78 years old · refraction: sphere +1 D, cylinder -1.5 D, axis 80° · visual field mean deviation: -6.75 dB · intraocular pressure (IOP): 20 mmHg · central corneal thickness 563 µm · sex: male
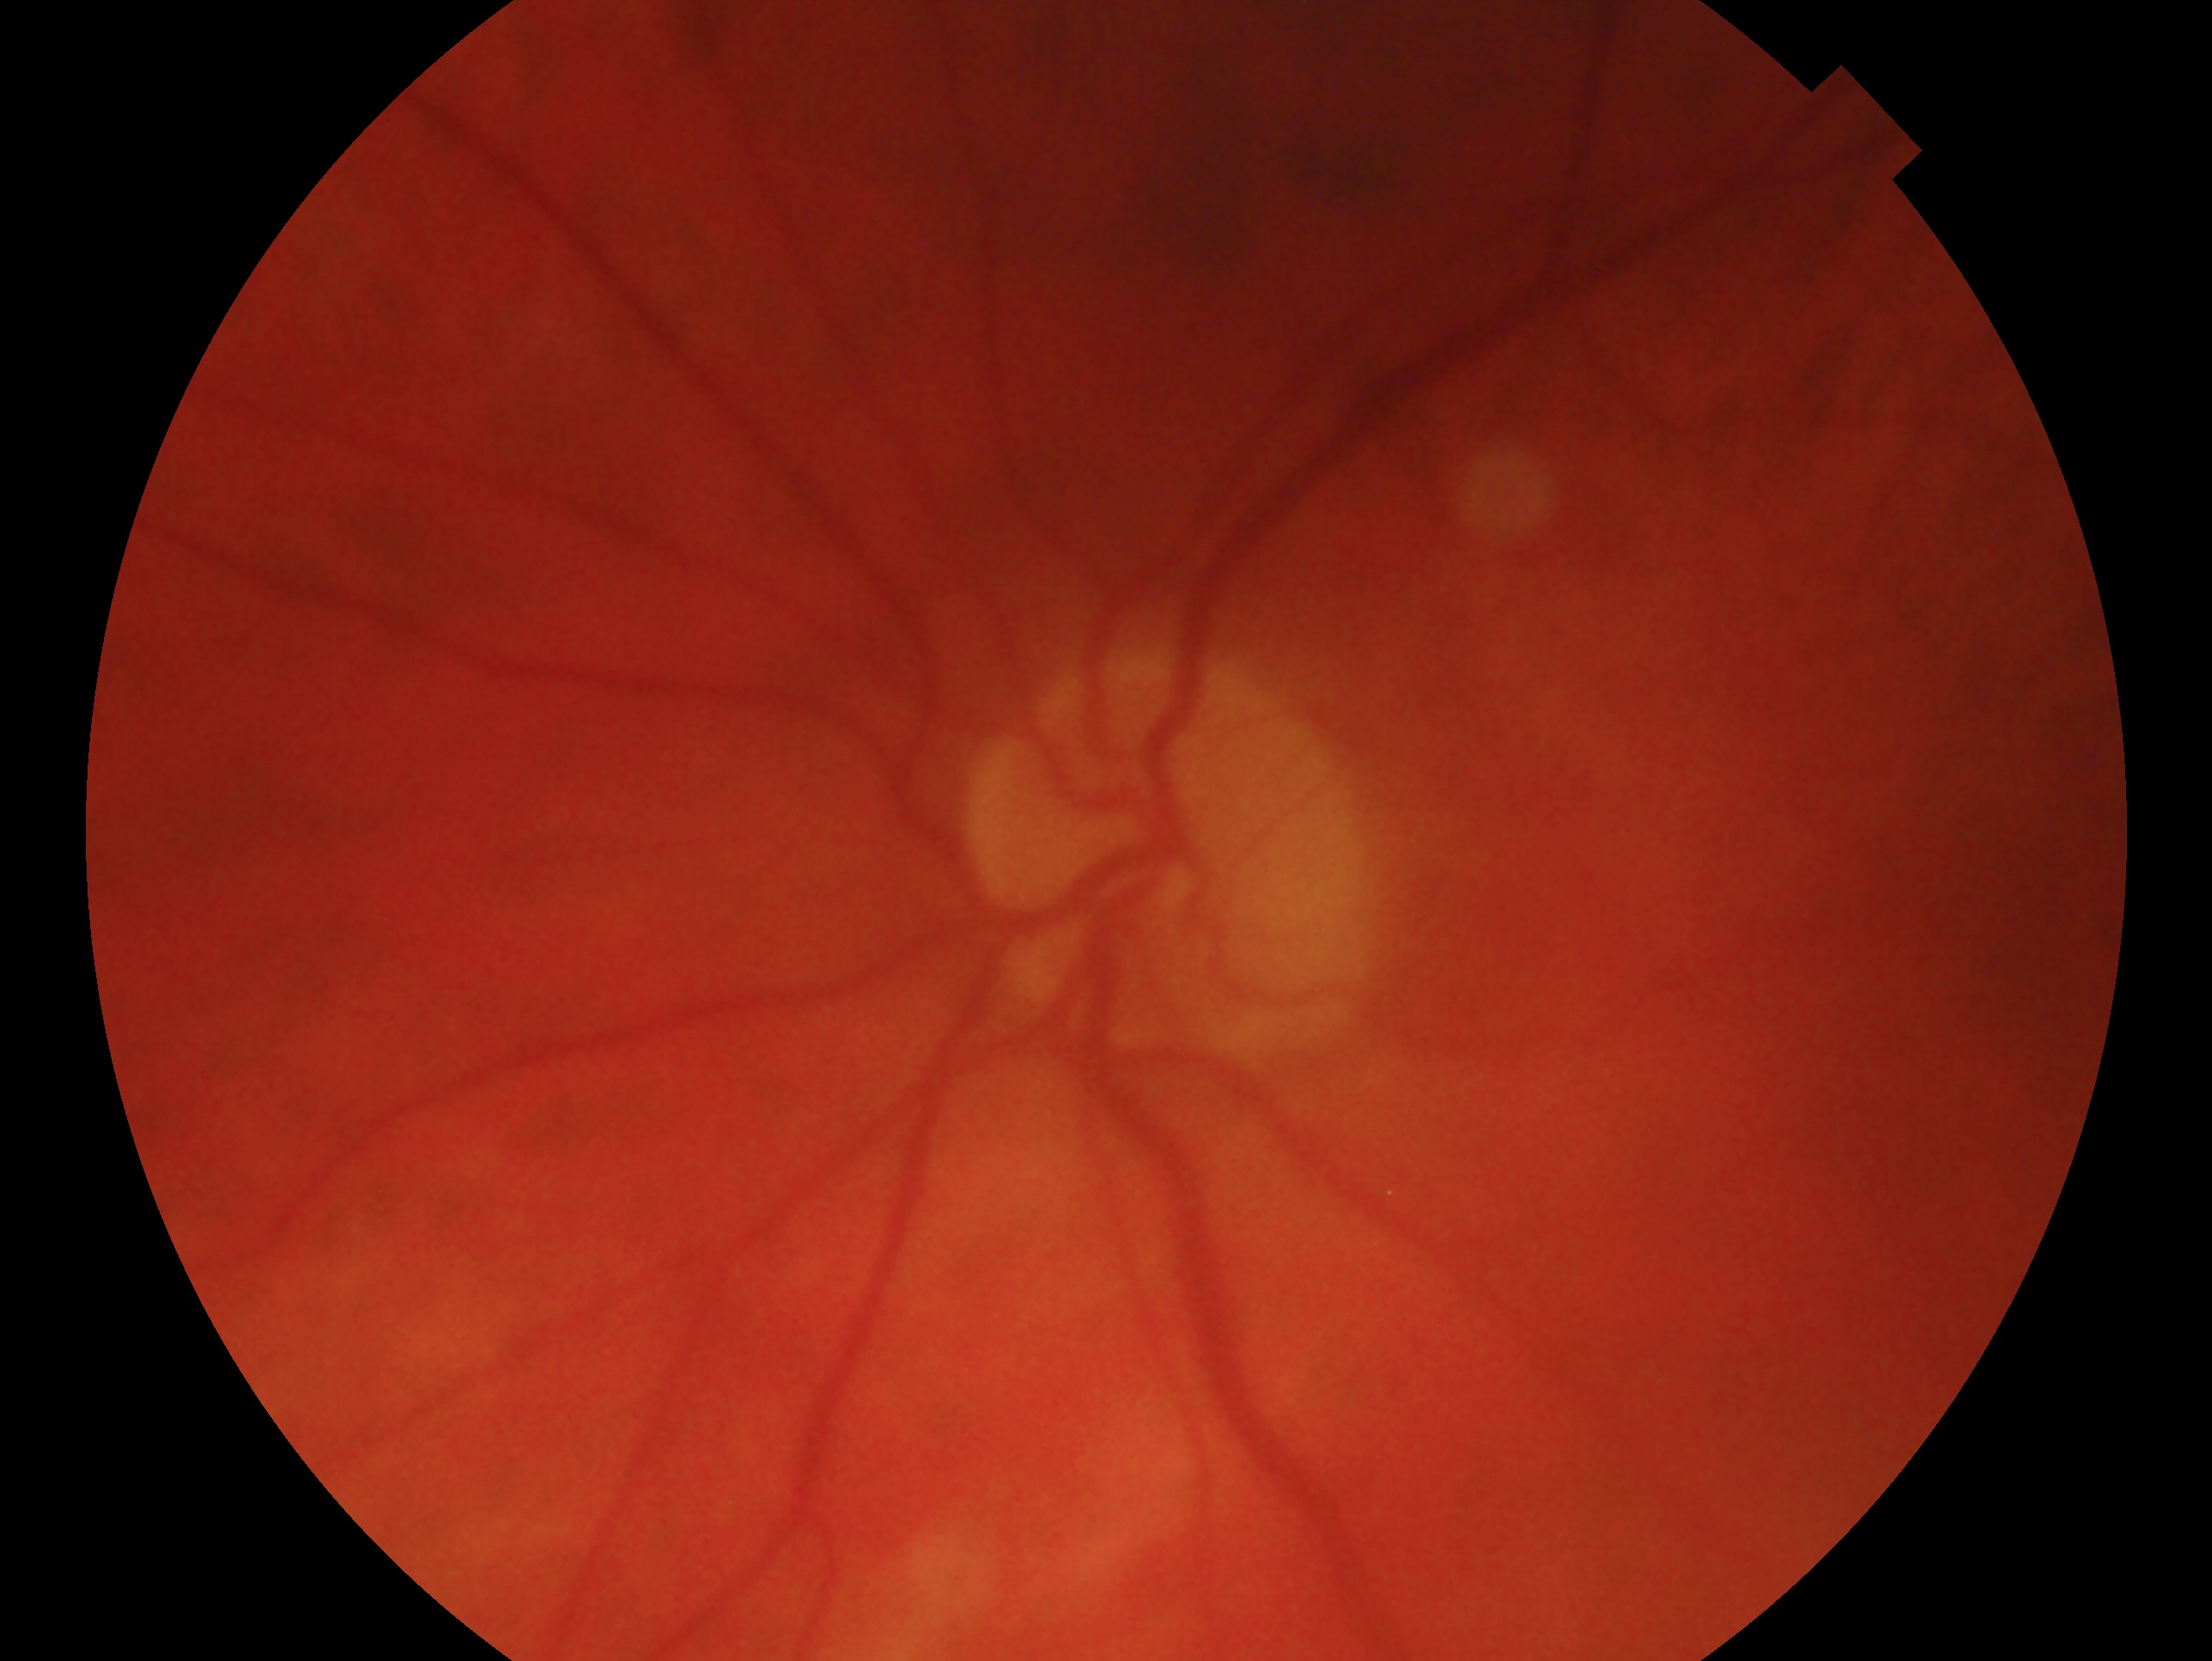
Findings:
– eye · OS
– clinical classification · glaucomatous optic neuropathy